Fundus photo; image size 2352x1568:
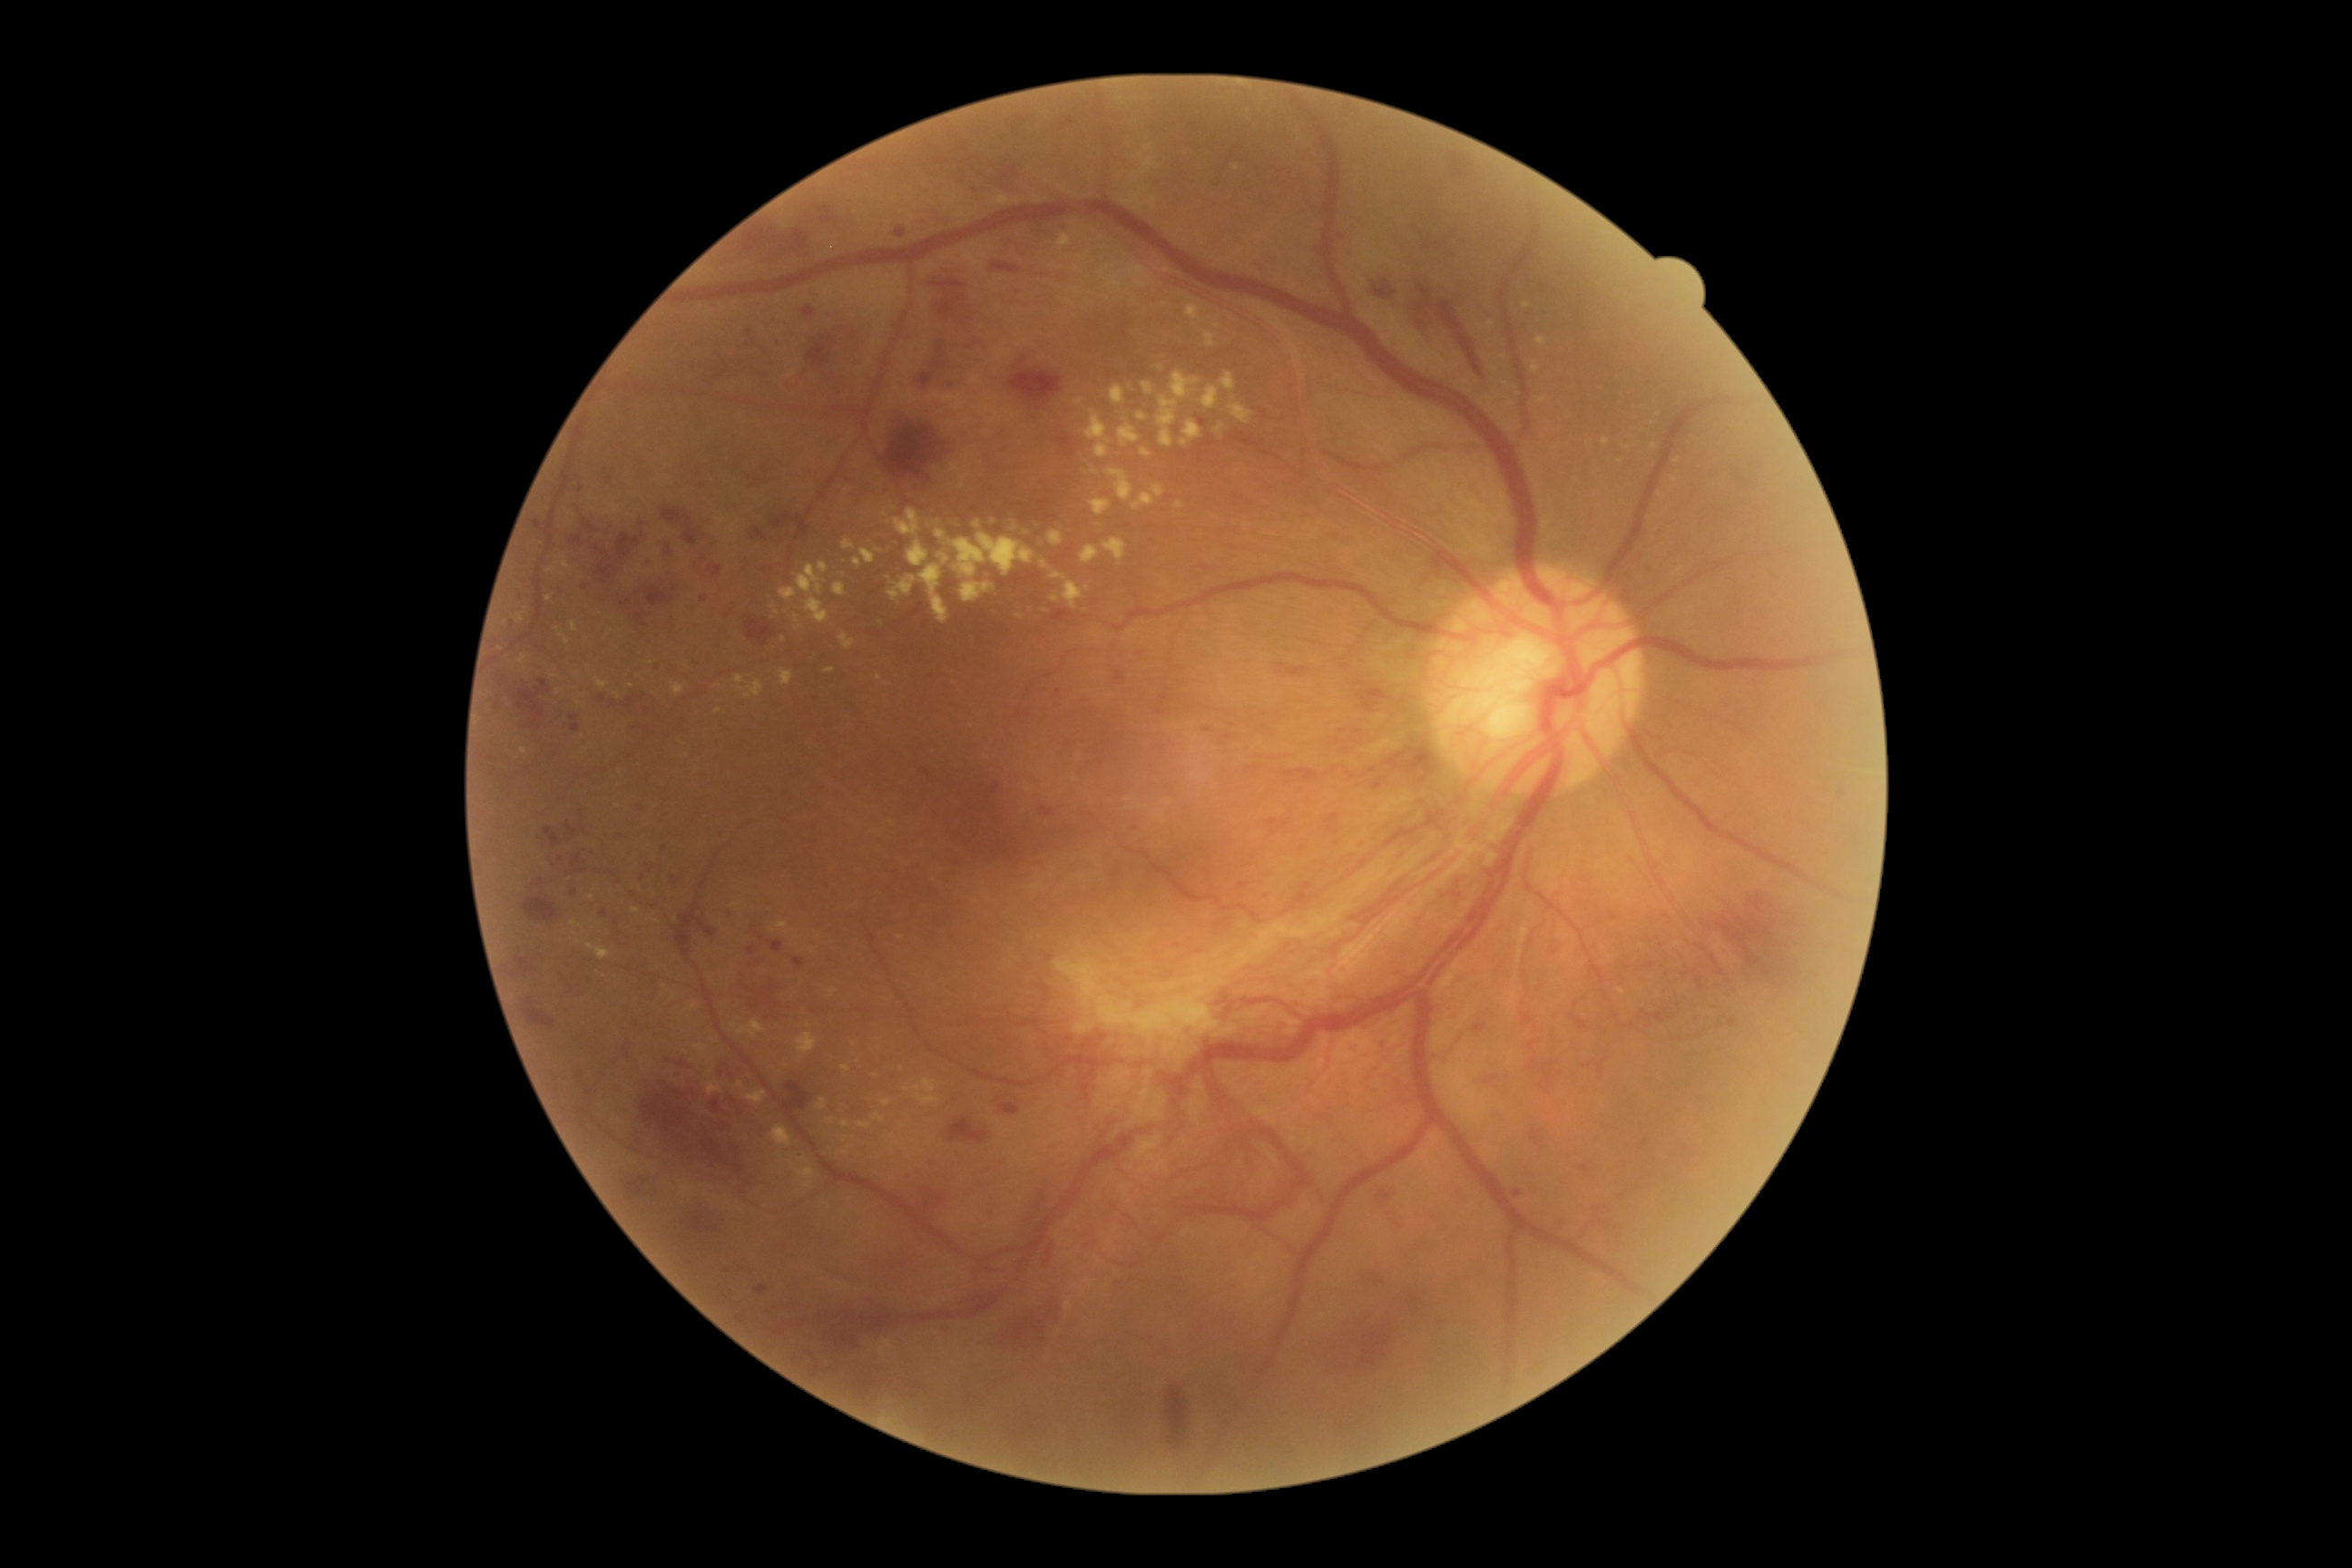
Diabetic retinopathy (DR) is PDR (grade 4).
Hard exudates (EXs) include lesions at left=852, top=558, right=863, bottom=567 | left=1106, top=469, right=1133, bottom=502 | left=1152, top=485, right=1164, bottom=498 | left=779, top=587, right=798, bottom=603 | left=518, top=656, right=527, bottom=665 | left=828, top=988, right=836, bottom=997 | left=1095, top=444, right=1110, bottom=458 | left=562, top=556, right=571, bottom=569 | left=1132, top=493, right=1155, bottom=511 | left=805, top=598, right=828, bottom=623.
Small EXs approximately at Point(550, 571) | Point(1236, 169) | Point(693, 1007) | Point(1166, 306) | Point(787, 1066) | Point(550, 599) | Point(1217, 326) | Point(977, 525).
Hemorrhages (HEs) include lesions at left=493, top=672, right=504, bottom=689 | left=1260, top=890, right=1271, bottom=897 | left=1409, top=1297, right=1422, bottom=1306 | left=660, top=504, right=718, bottom=549 | left=796, top=516, right=808, bottom=538 | left=1732, top=466, right=1765, bottom=495 | left=1558, top=1220, right=1565, bottom=1230 | left=843, top=1318, right=896, bottom=1346 | left=642, top=861, right=654, bottom=881 | left=785, top=1083, right=812, bottom=1113 | left=1063, top=117, right=1075, bottom=124 | left=1275, top=662, right=1313, bottom=676 | left=1028, top=226, right=1055, bottom=240 | left=994, top=1286, right=1068, bottom=1357 | left=700, top=914, right=714, bottom=936 | left=1531, top=1130, right=1542, bottom=1144 | left=507, top=968, right=520, bottom=985.
Small HEs approximately at Point(1016, 129) | Point(927, 774).